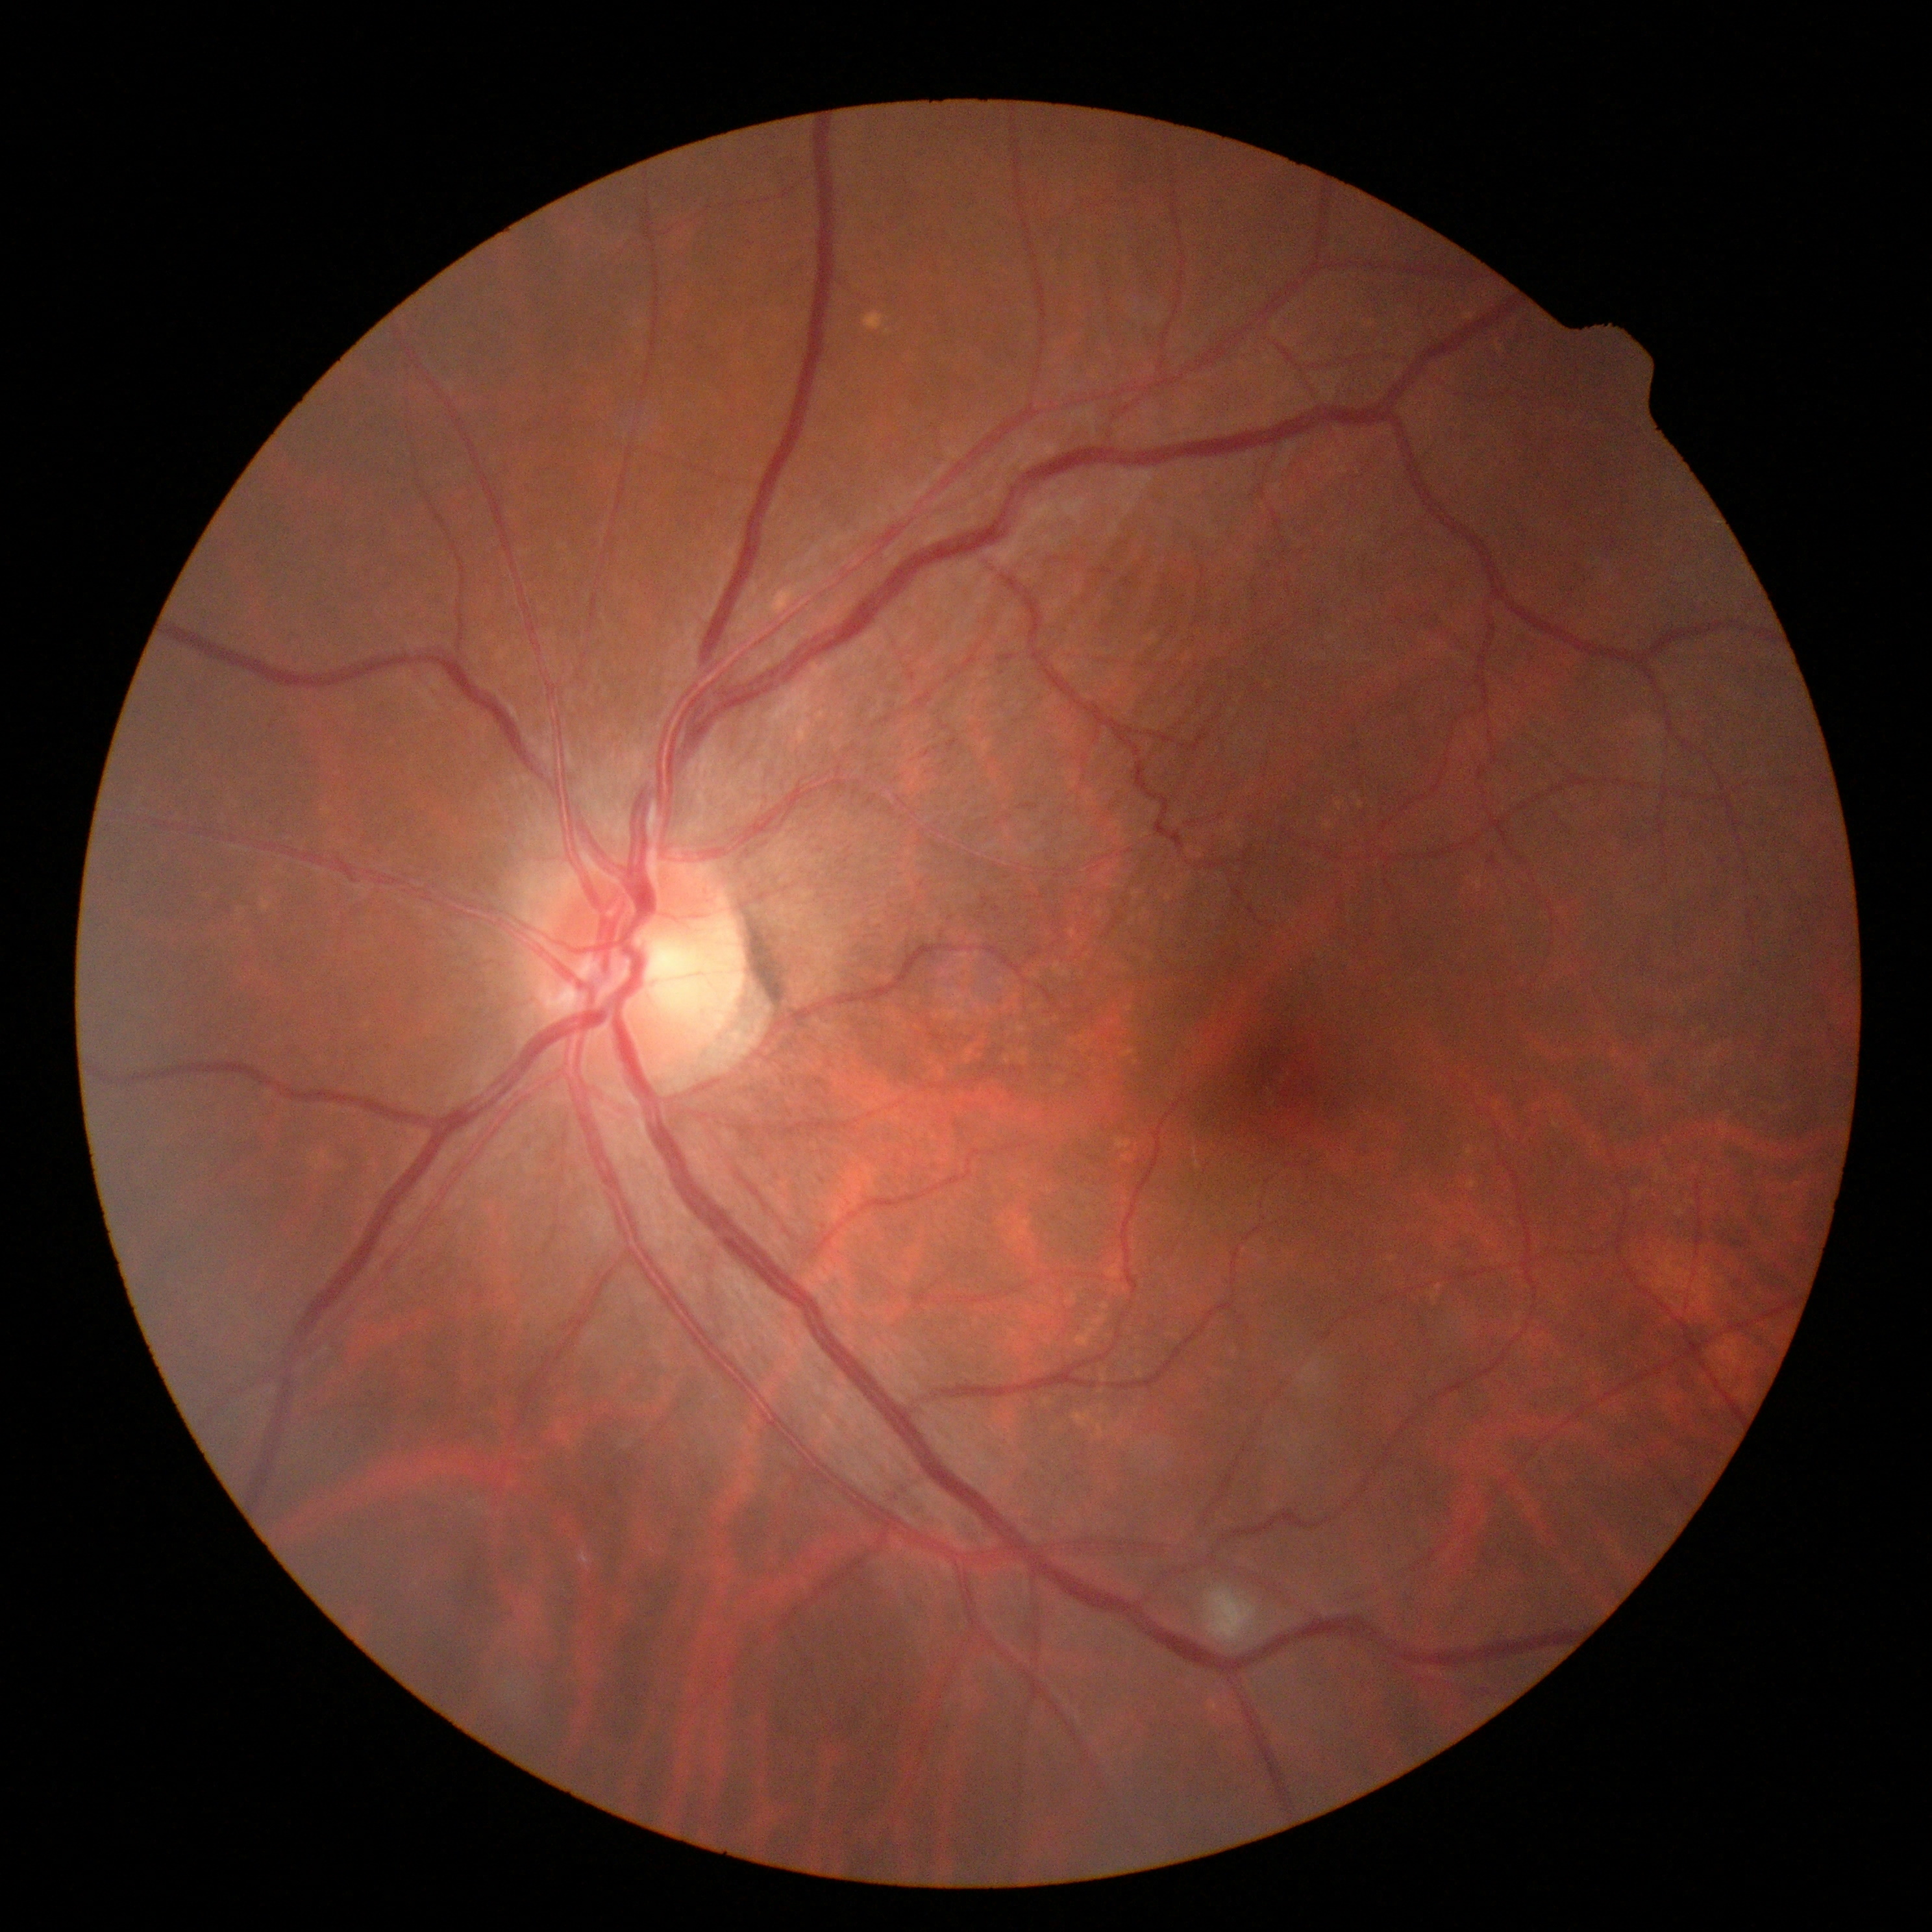
Diabetic retinopathy grade: moderate NPDR (2).